Color fundus photograph centered on the optic disc: 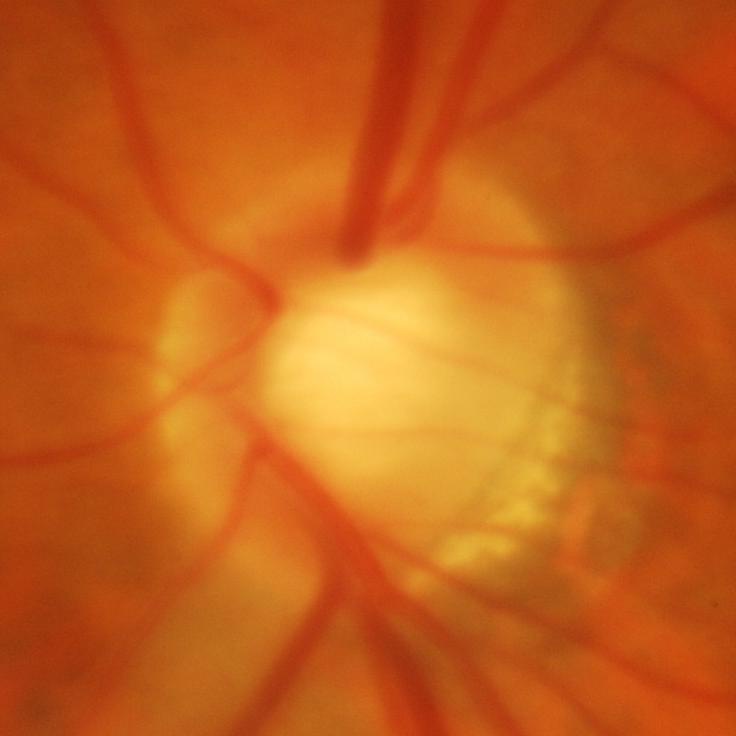
Glaucoma.